Camera: Phoenix ICON (100° FOV); 1240x1240px; wide-field fundus photograph of an infant
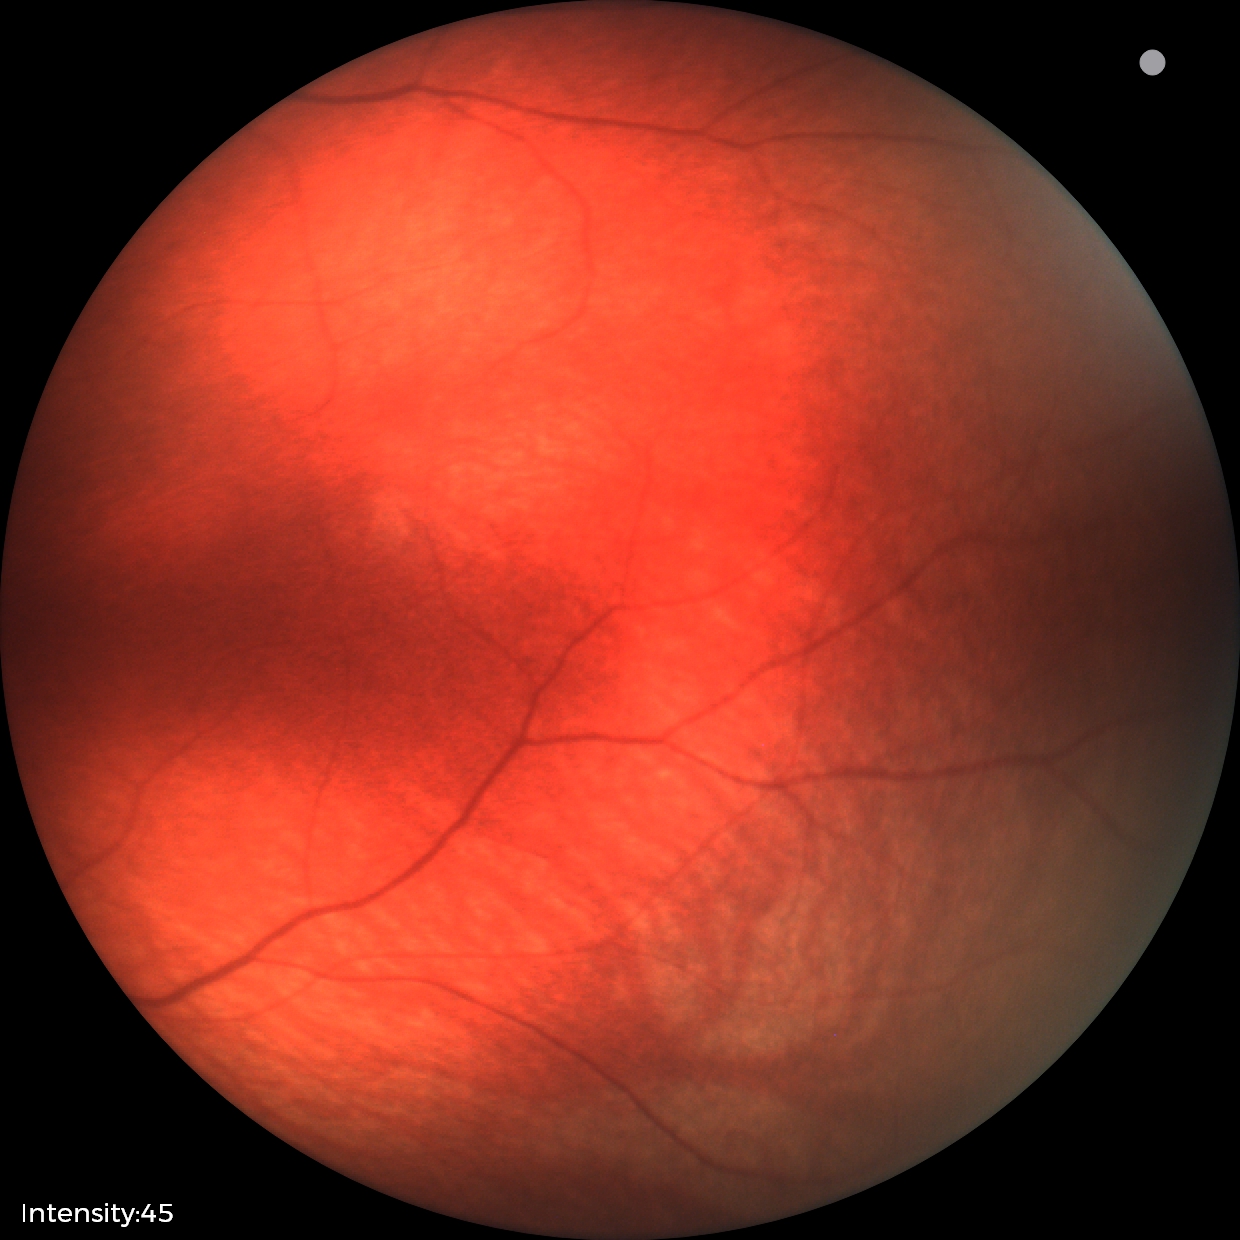

Screening examination diagnosed as physiological.